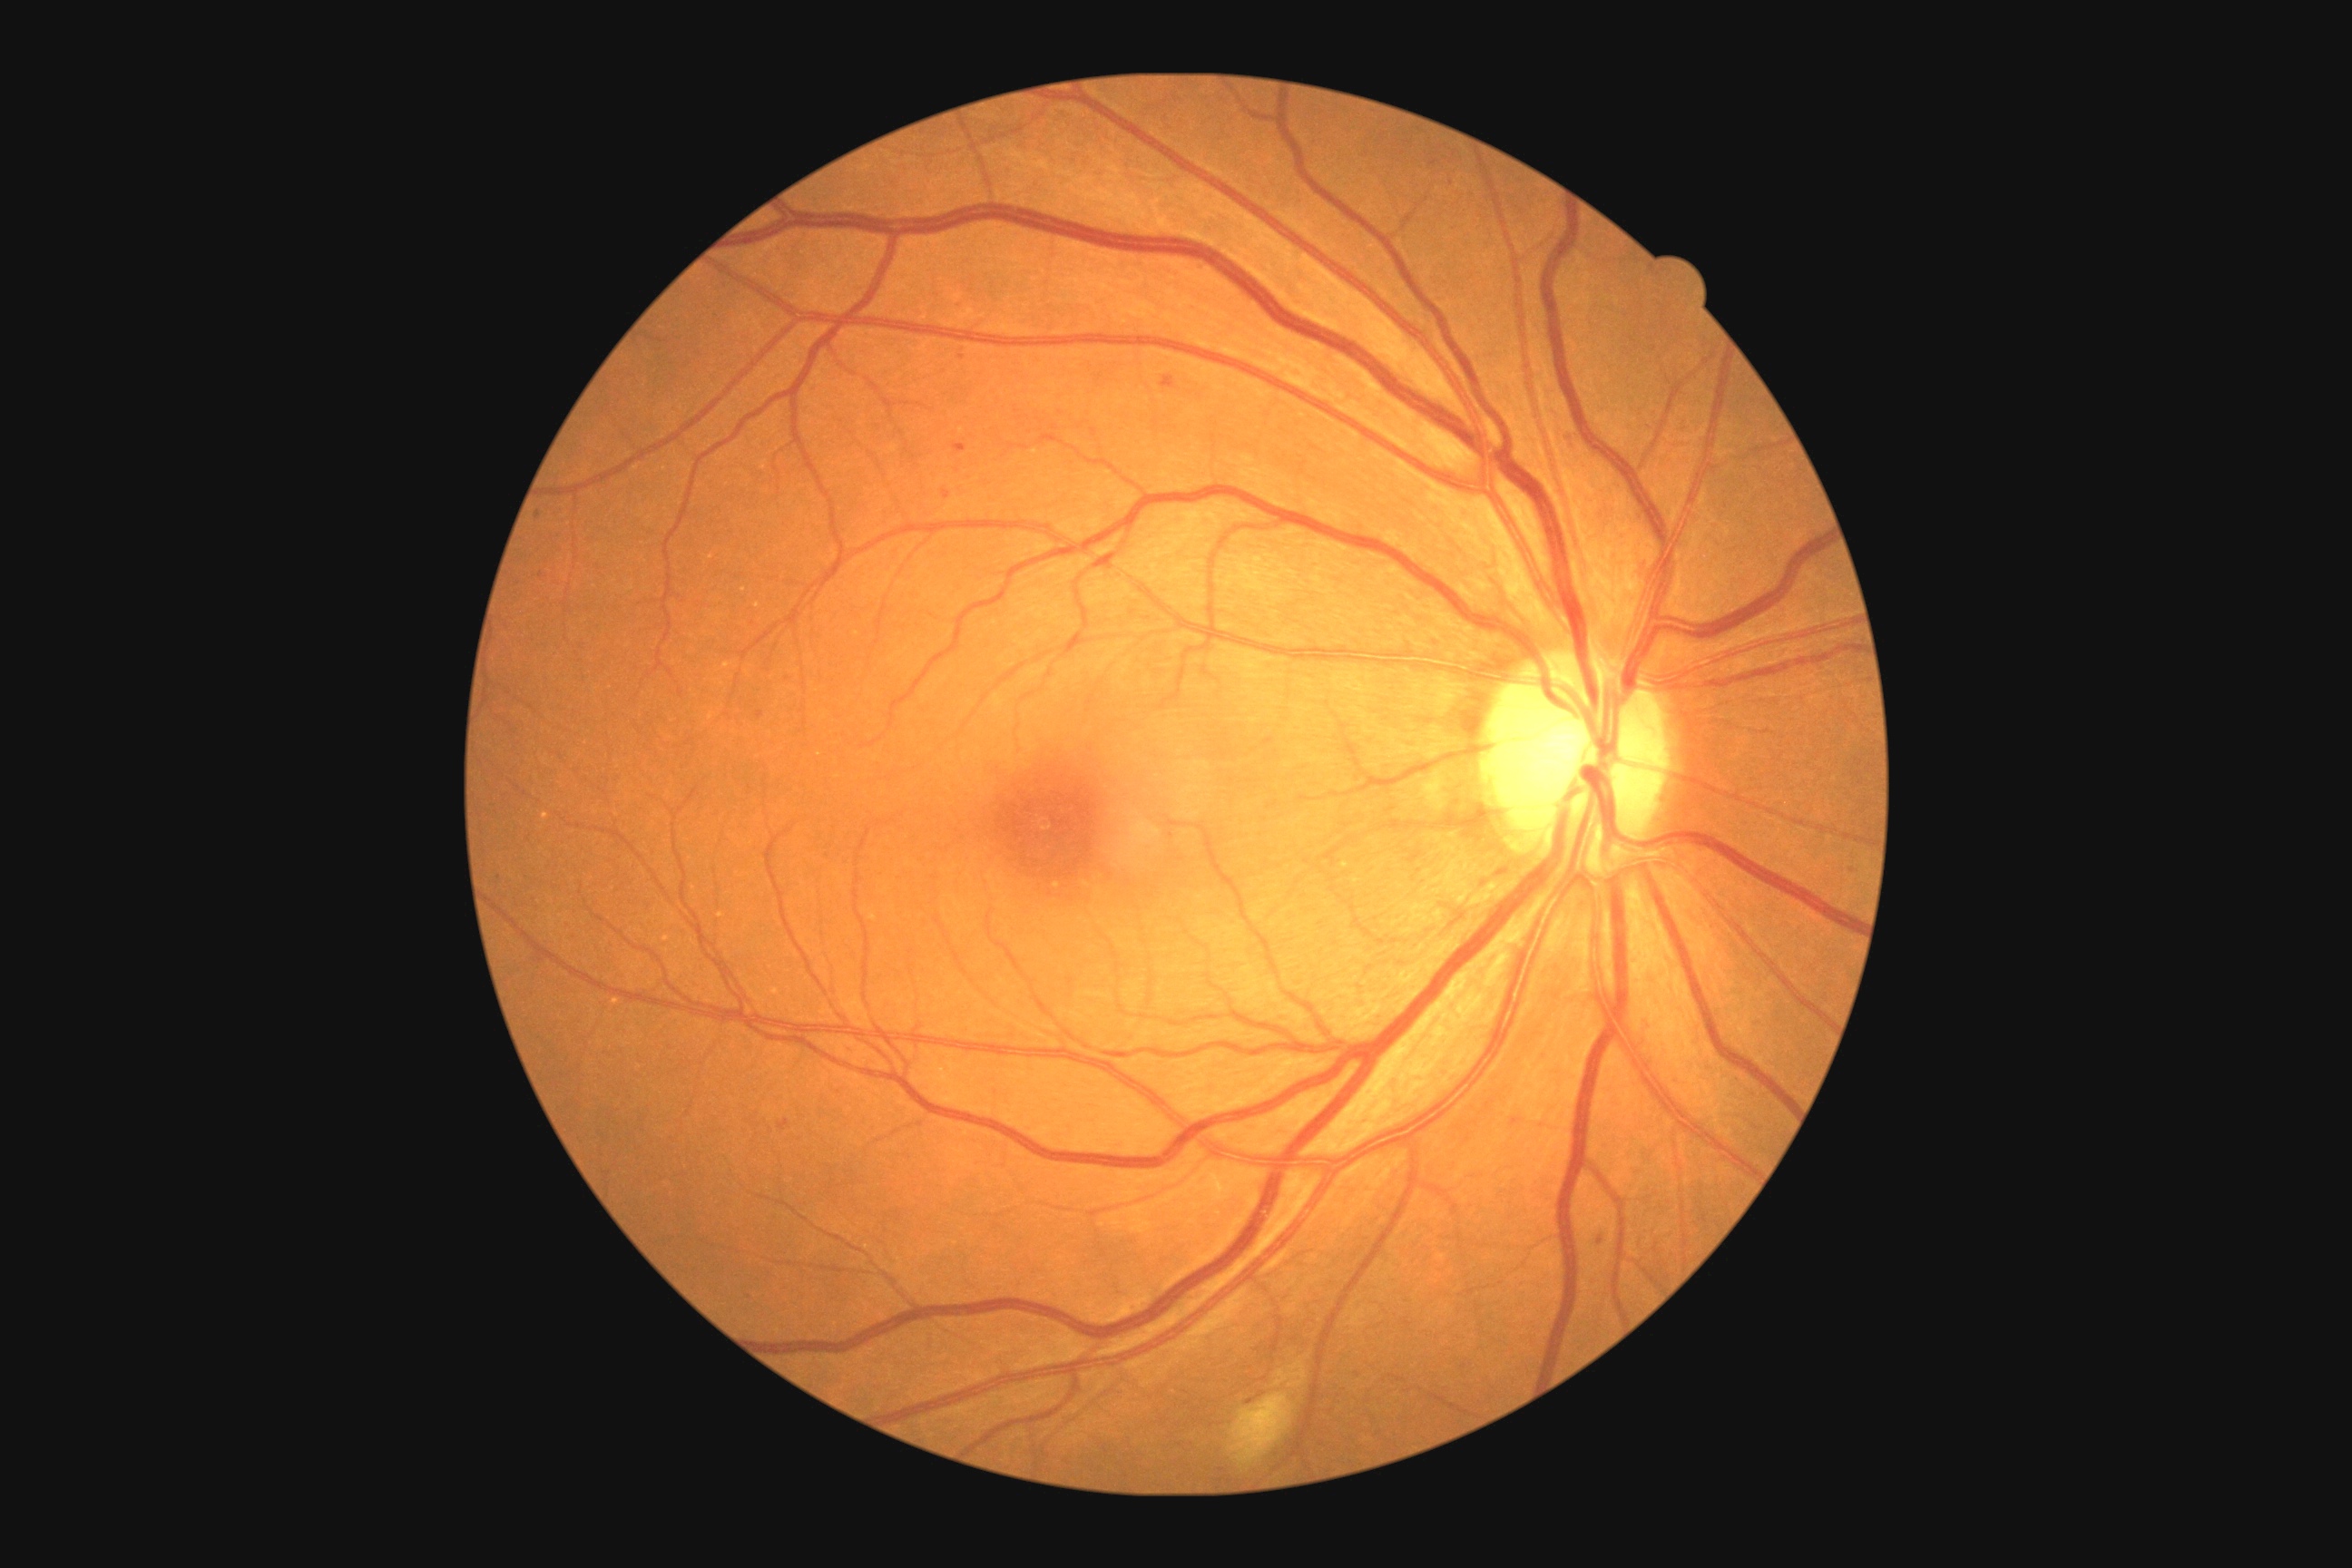
Retinopathy is 2/4.